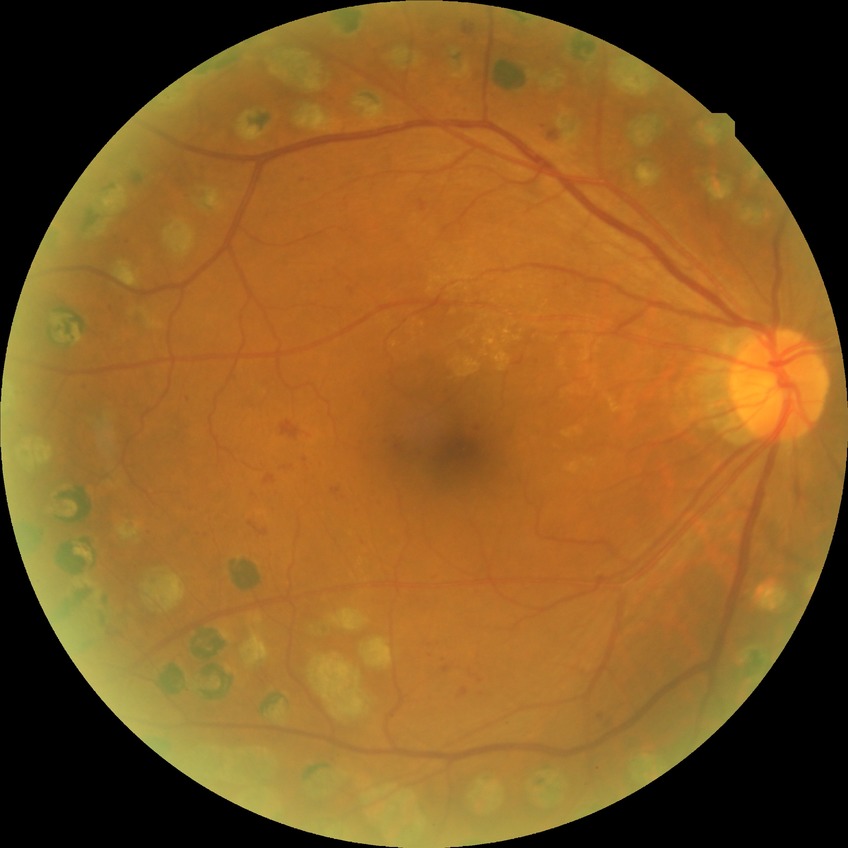 diabetic retinopathy grade: proliferative diabetic retinopathy.